FOV: 45 degrees.
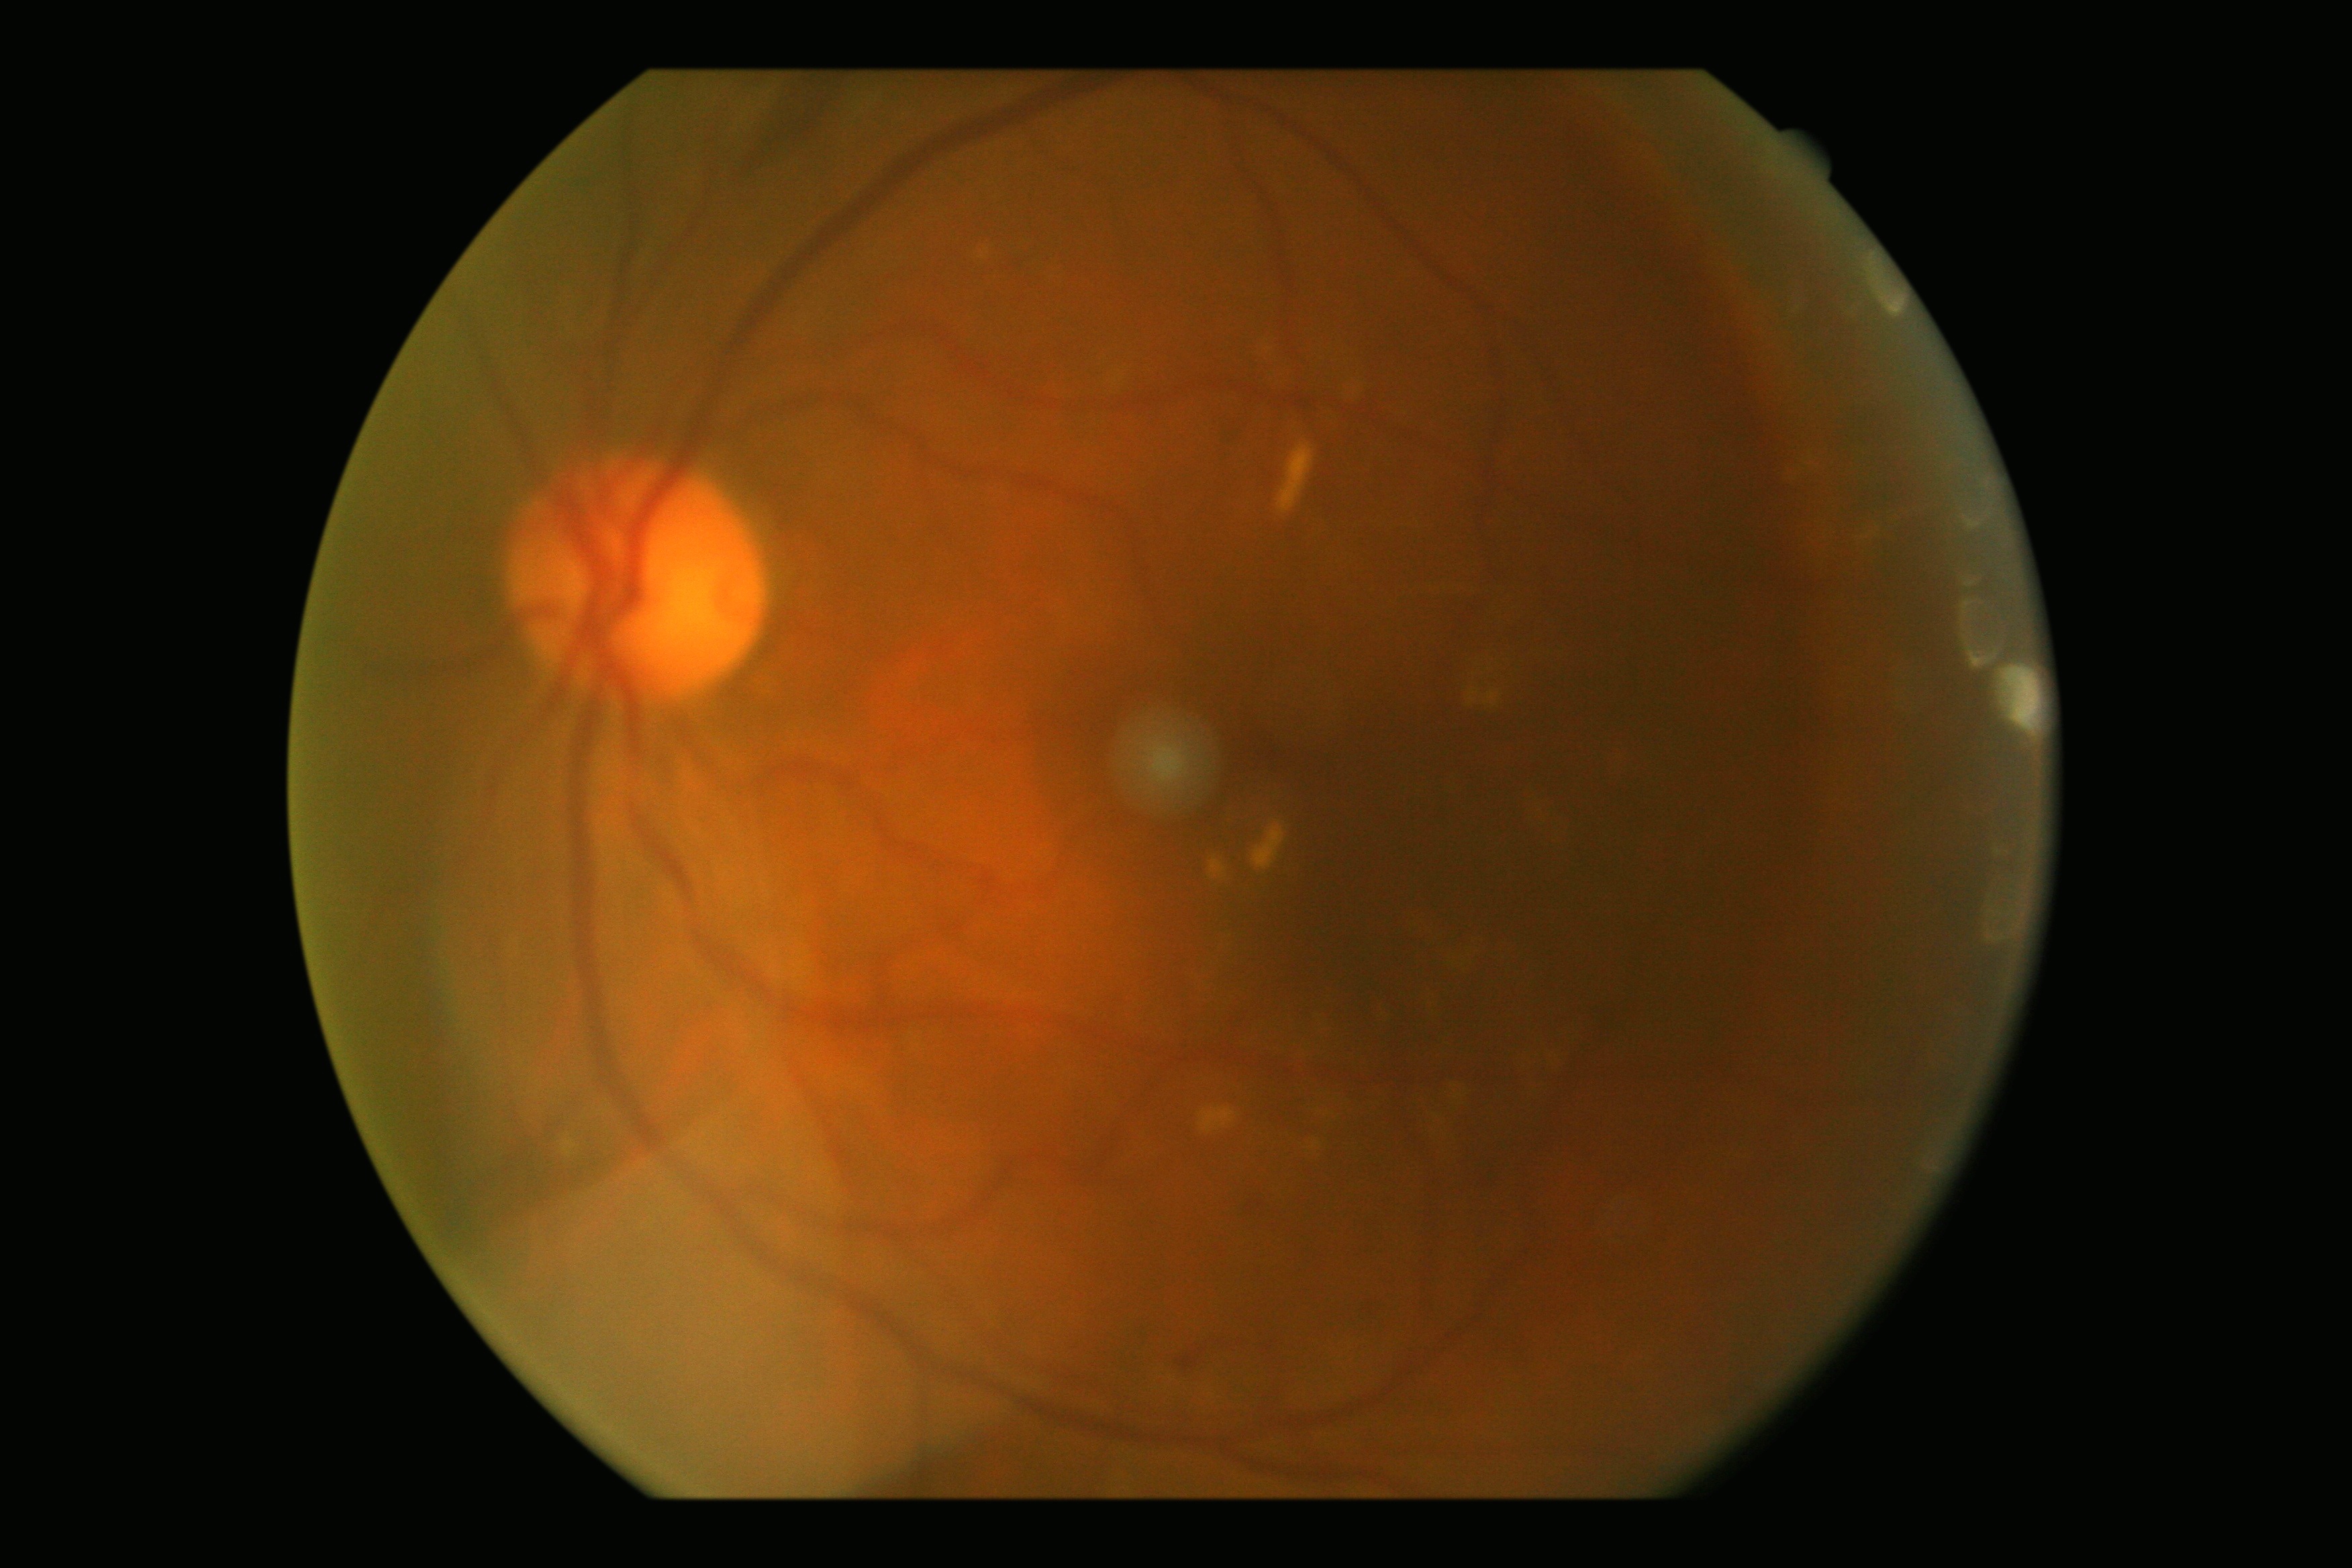

Diabetic retinopathy is 2/4.